CFP.
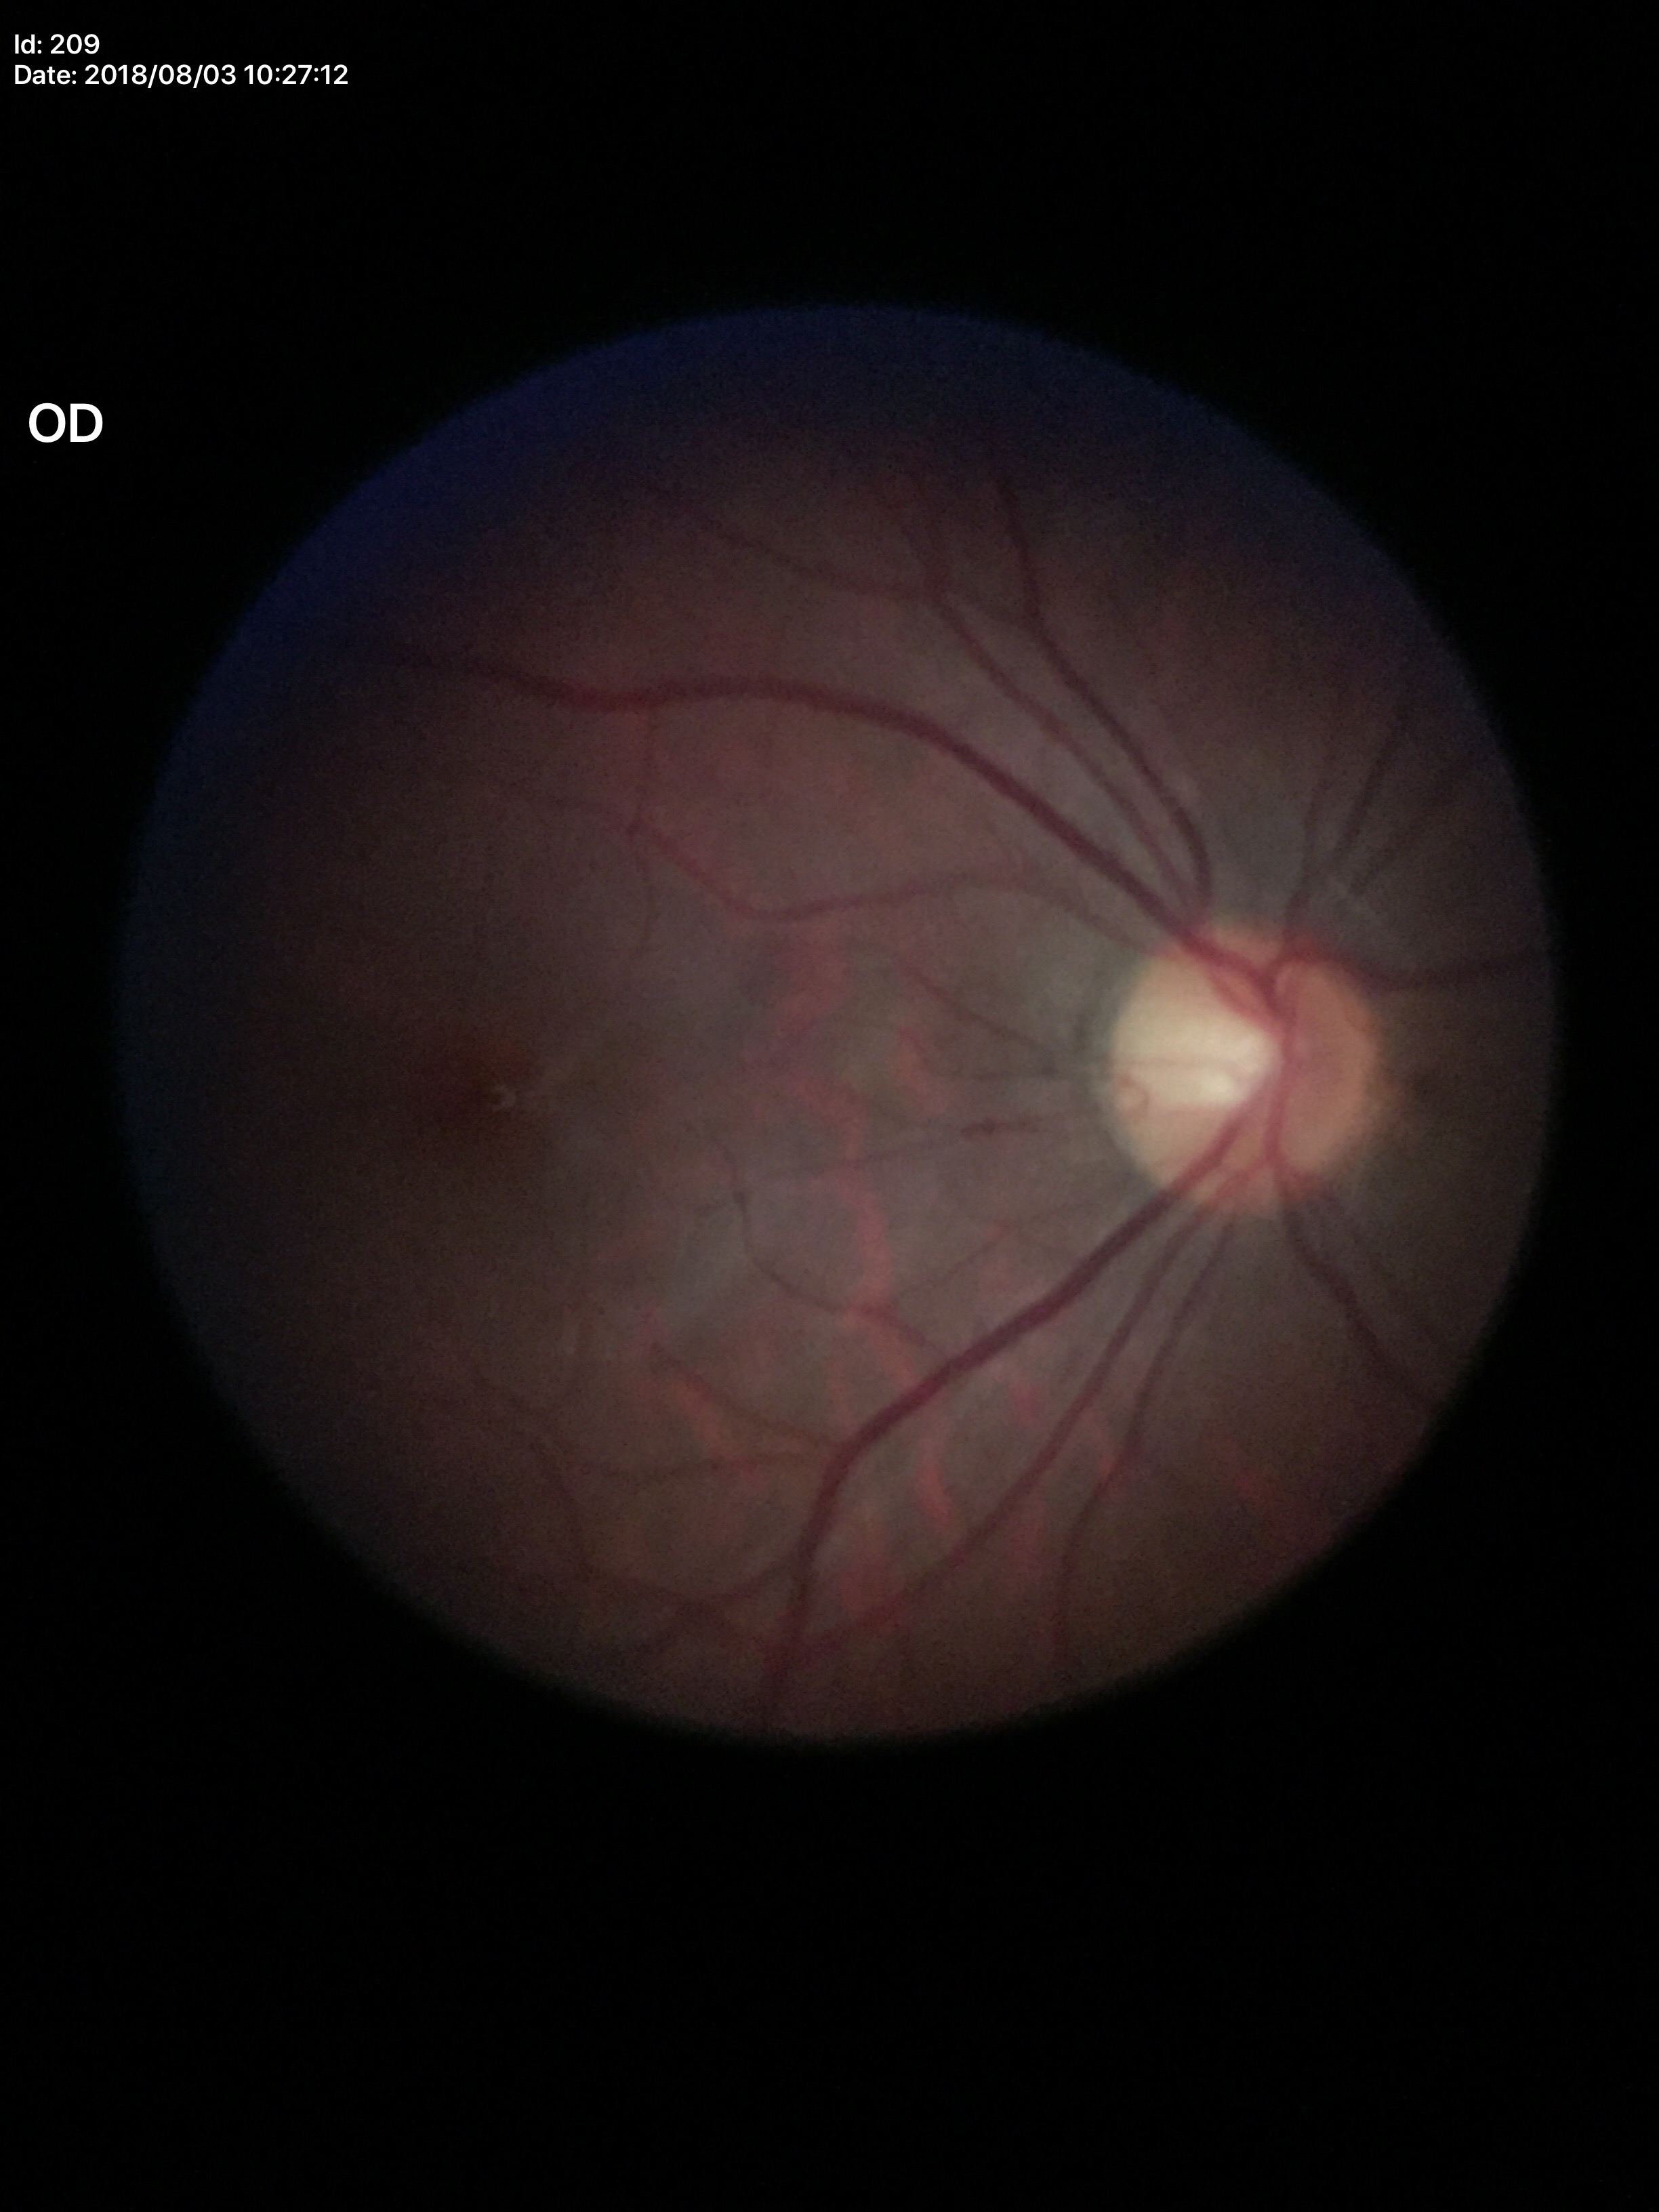 glaucoma_decision: not suspect
hcdr: 0.46
vcdr: 0.42